CFP, 2212x1659px, 45° field of view:
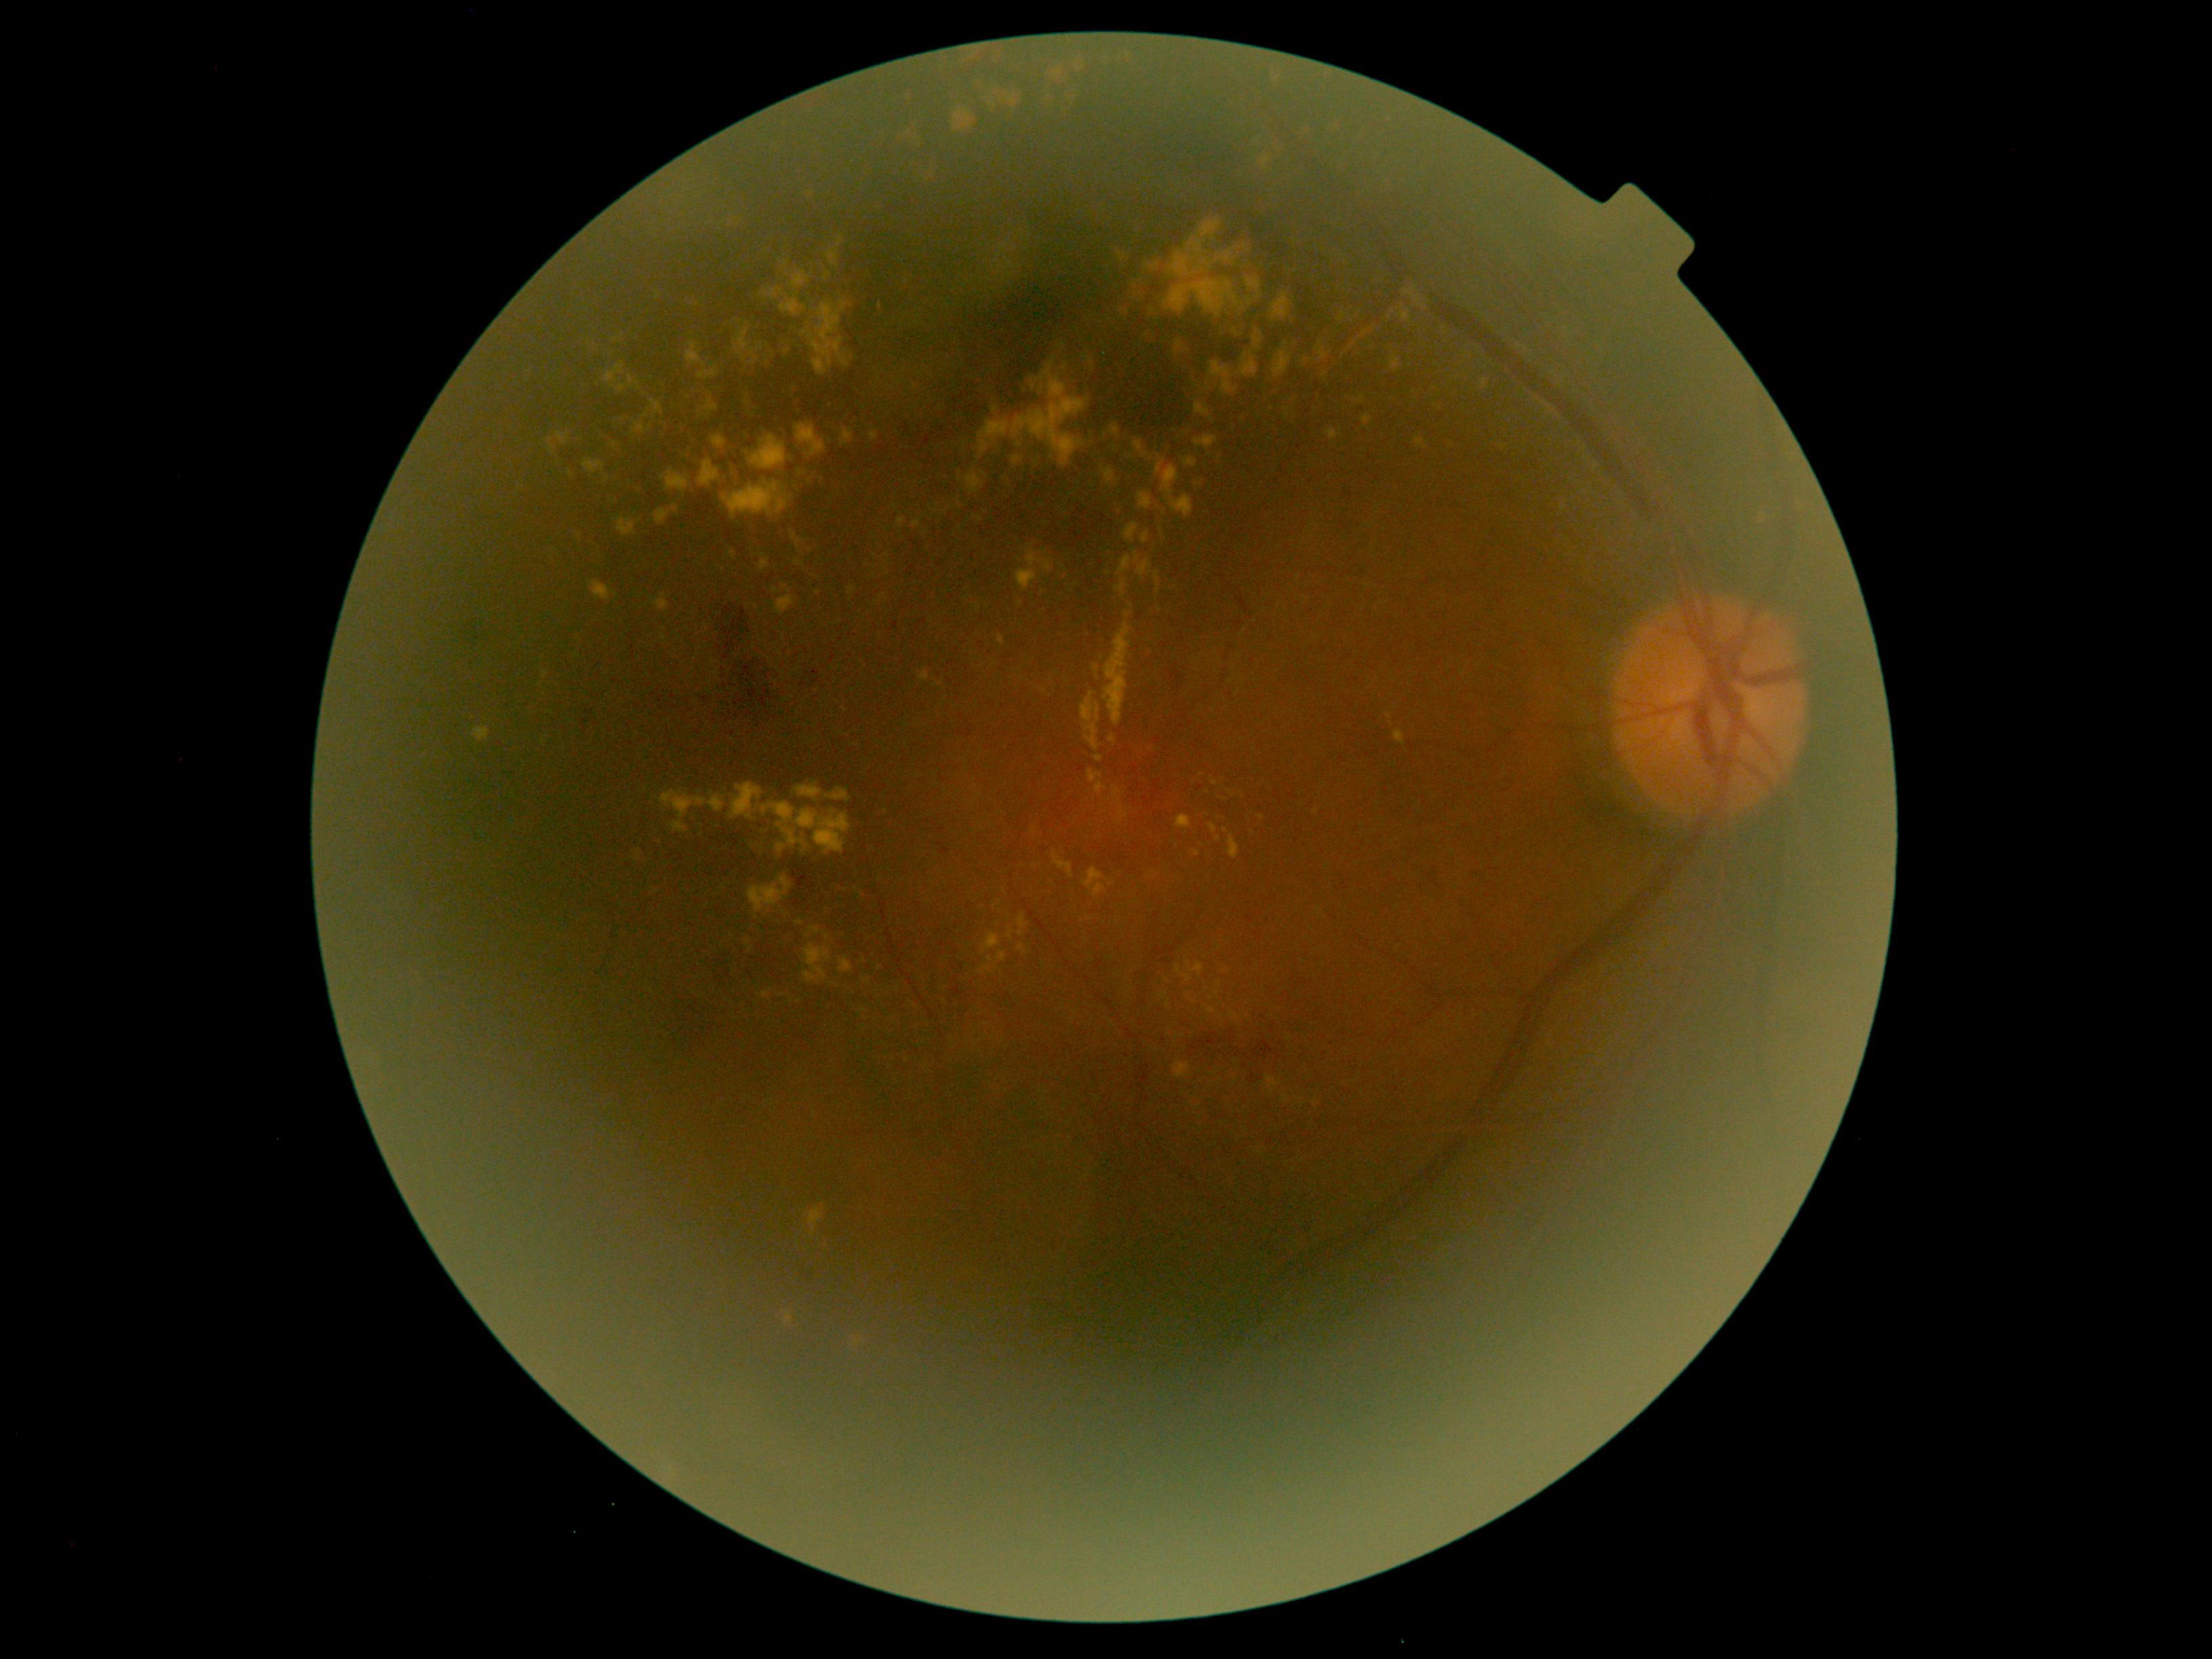
Diabetic retinopathy (DR) is 2/4
Representative lesions:
hemorrhages (HEs) (continued): [x1=790, y1=857, x2=817, y2=909]; [x1=457, y1=620, x2=487, y2=657]; [x1=1212, y1=1047, x2=1253, y2=1062]; [x1=579, y1=704, x2=600, y2=737]; [x1=659, y1=1000, x2=731, y2=1058]; [x1=593, y1=659, x2=604, y2=670]; [x1=1082, y1=303, x2=1218, y2=437]; [x1=1166, y1=668, x2=1184, y2=692]; [x1=940, y1=848, x2=951, y2=856]; [x1=958, y1=729, x2=975, y2=739]
Additional small HEs near <pt>1245,1066</pt>
hard exudates (EXs) (continued): [x1=978, y1=359, x2=1090, y2=468]; [x1=1313, y1=1099, x2=1318, y2=1107]; [x1=1160, y1=993, x2=1166, y2=1001]; [x1=747, y1=434, x2=791, y2=470]; [x1=1405, y1=287, x2=1422, y2=307]; [x1=1517, y1=344, x2=1528, y2=350]; [x1=556, y1=432, x2=571, y2=445]; [x1=1416, y1=438, x2=1427, y2=449]; [x1=616, y1=375, x2=640, y2=394]; [x1=785, y1=1314, x2=794, y2=1325]; [x1=1054, y1=852, x2=1074, y2=879]; [x1=1184, y1=457, x2=1197, y2=468]; [x1=704, y1=399, x2=719, y2=417]
Additional small EXs near <pt>1201,846</pt>; <pt>979,520</pt>; <pt>979,606</pt>; <pt>865,1010</pt>; <pt>881,306</pt>; <pt>1062,345</pt>; <pt>1198,483</pt>